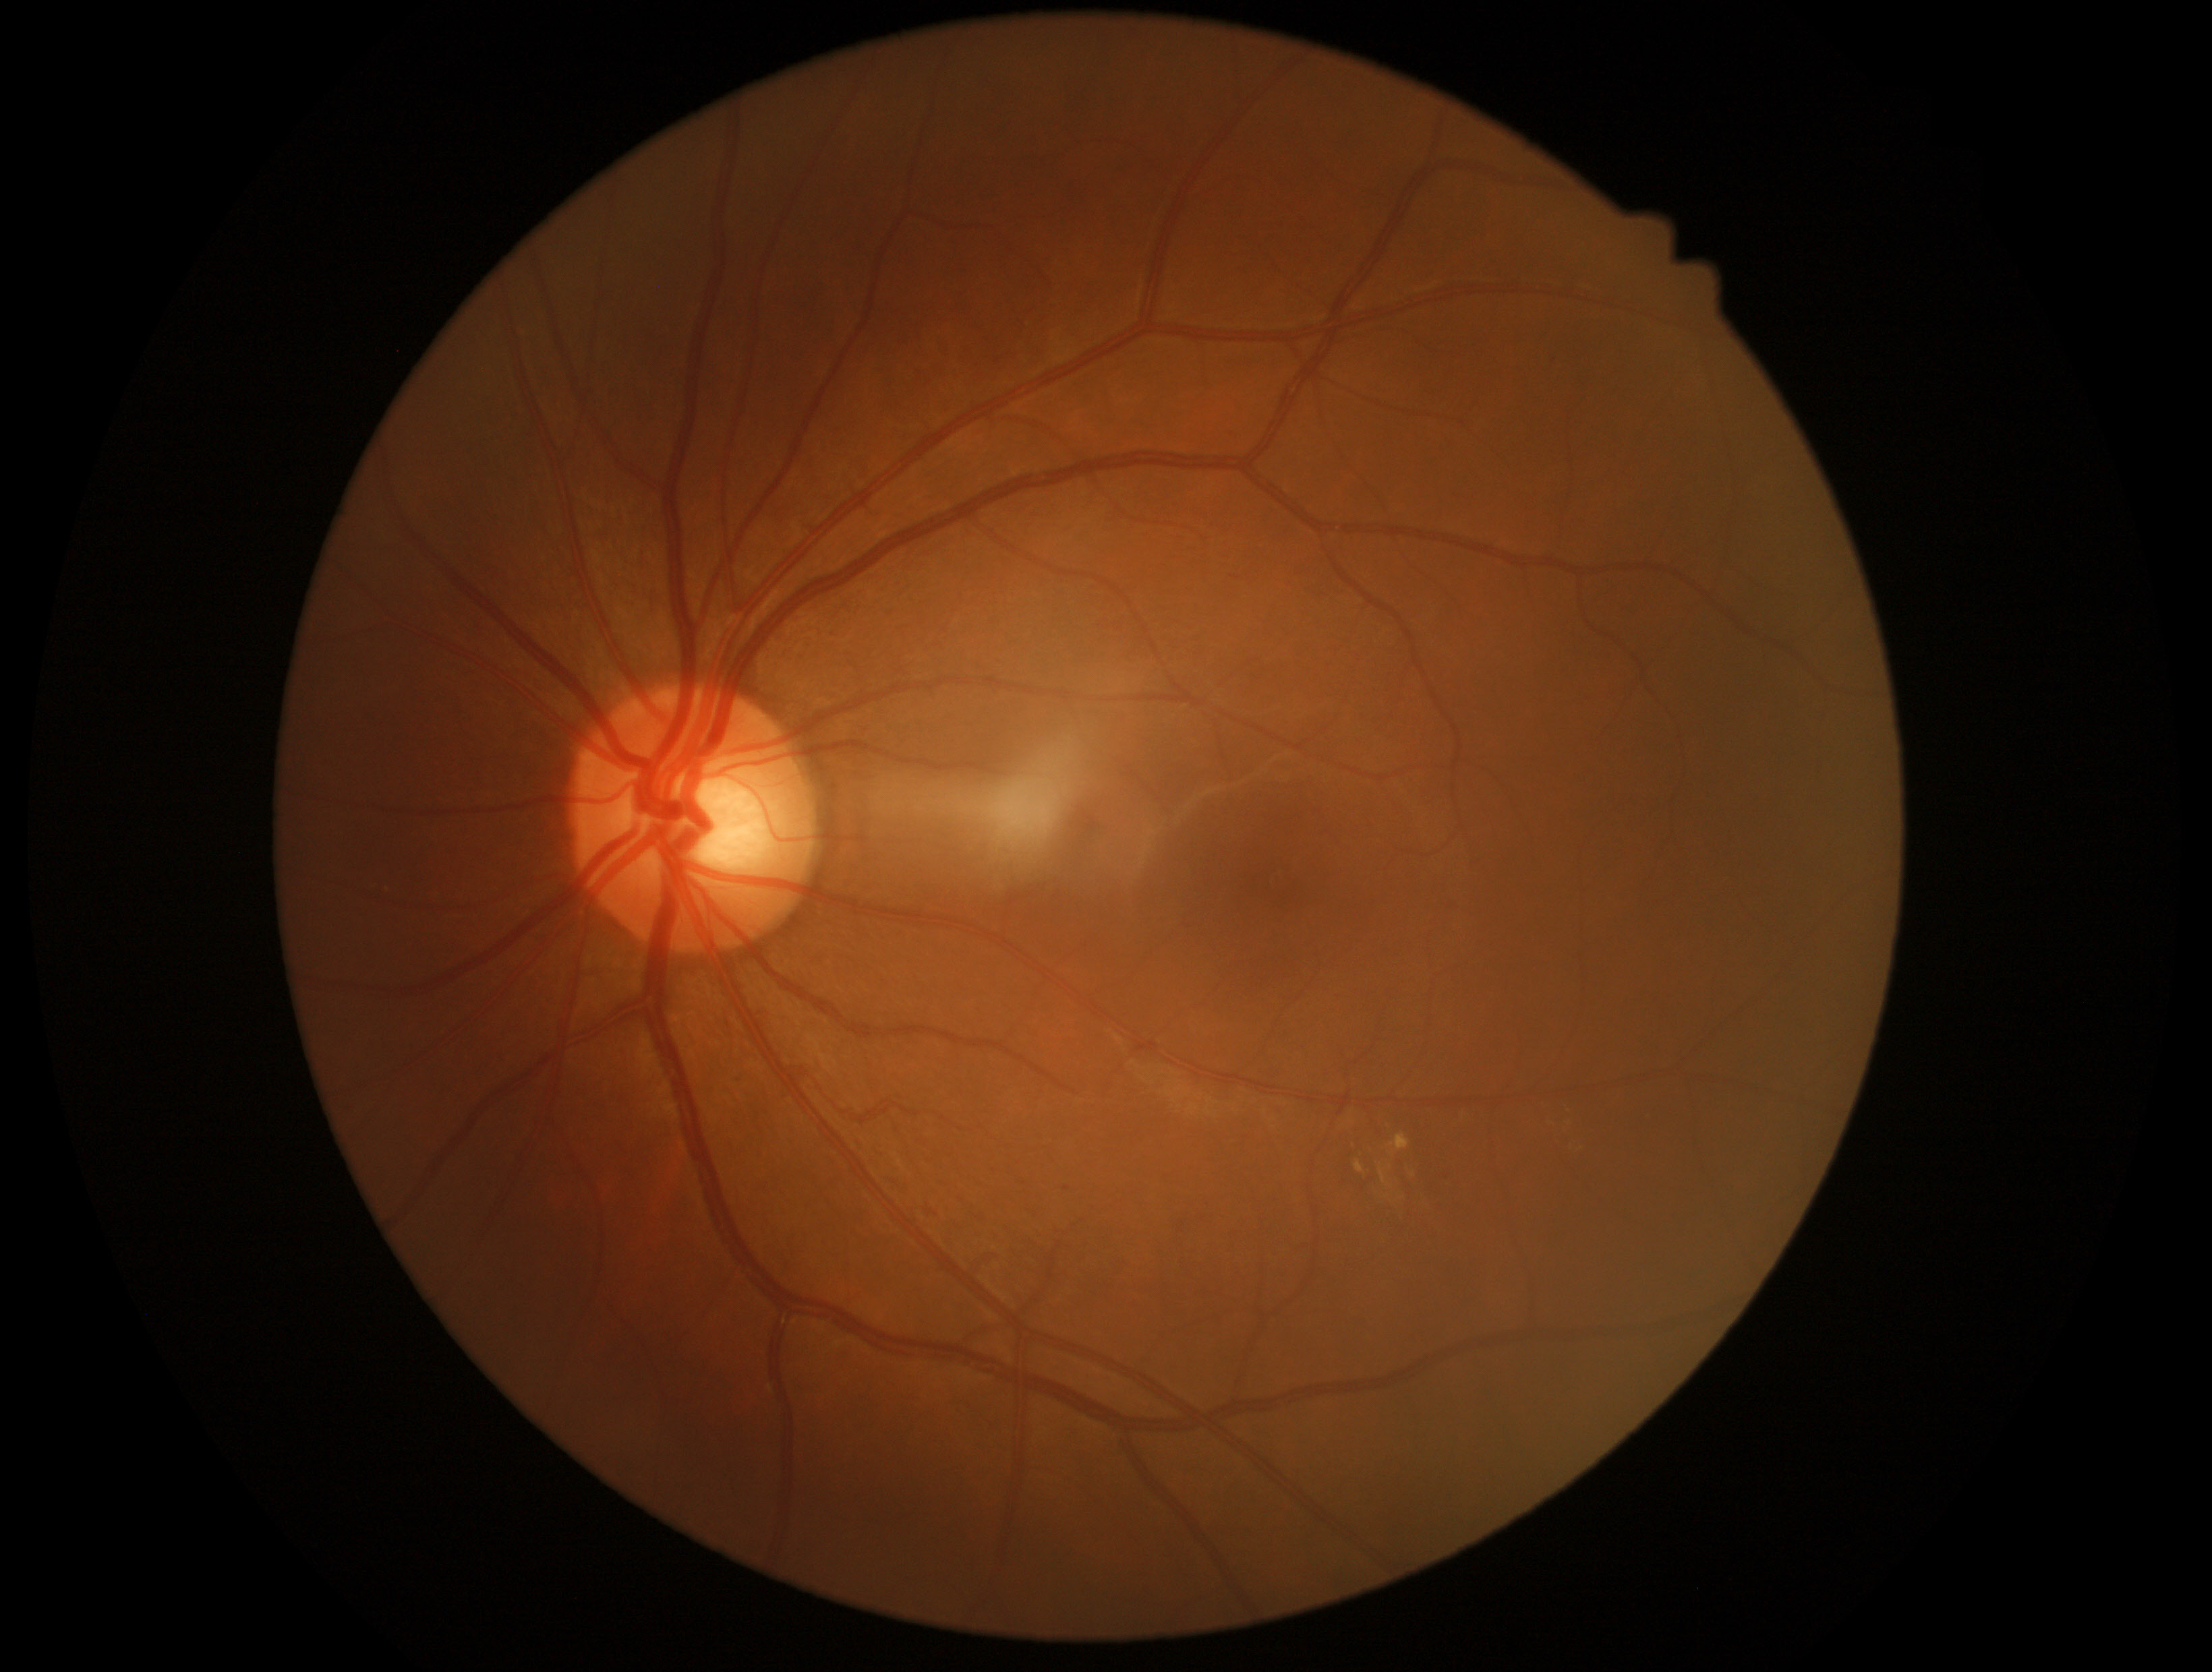 Retinopathy grade is 2 — more than just microaneurysms but less than severe NPDR
A subset of detected lesions:
hard exudates (subset): [1573, 1141, 1585, 1150]; [1411, 1170, 1422, 1182]; [1542, 1104, 1549, 1114]; [1387, 1135, 1410, 1156]; [1355, 1162, 1366, 1174]; [1380, 1166, 1391, 1189]
Small hard exudates near <point>1567, 1109</point>; <point>1390, 1168</point>
soft exudates: absent
hemorrhages: absent
microaneurysms: [1440, 1170, 1448, 1179]
Small microaneurysms near <point>1067, 1189</point>